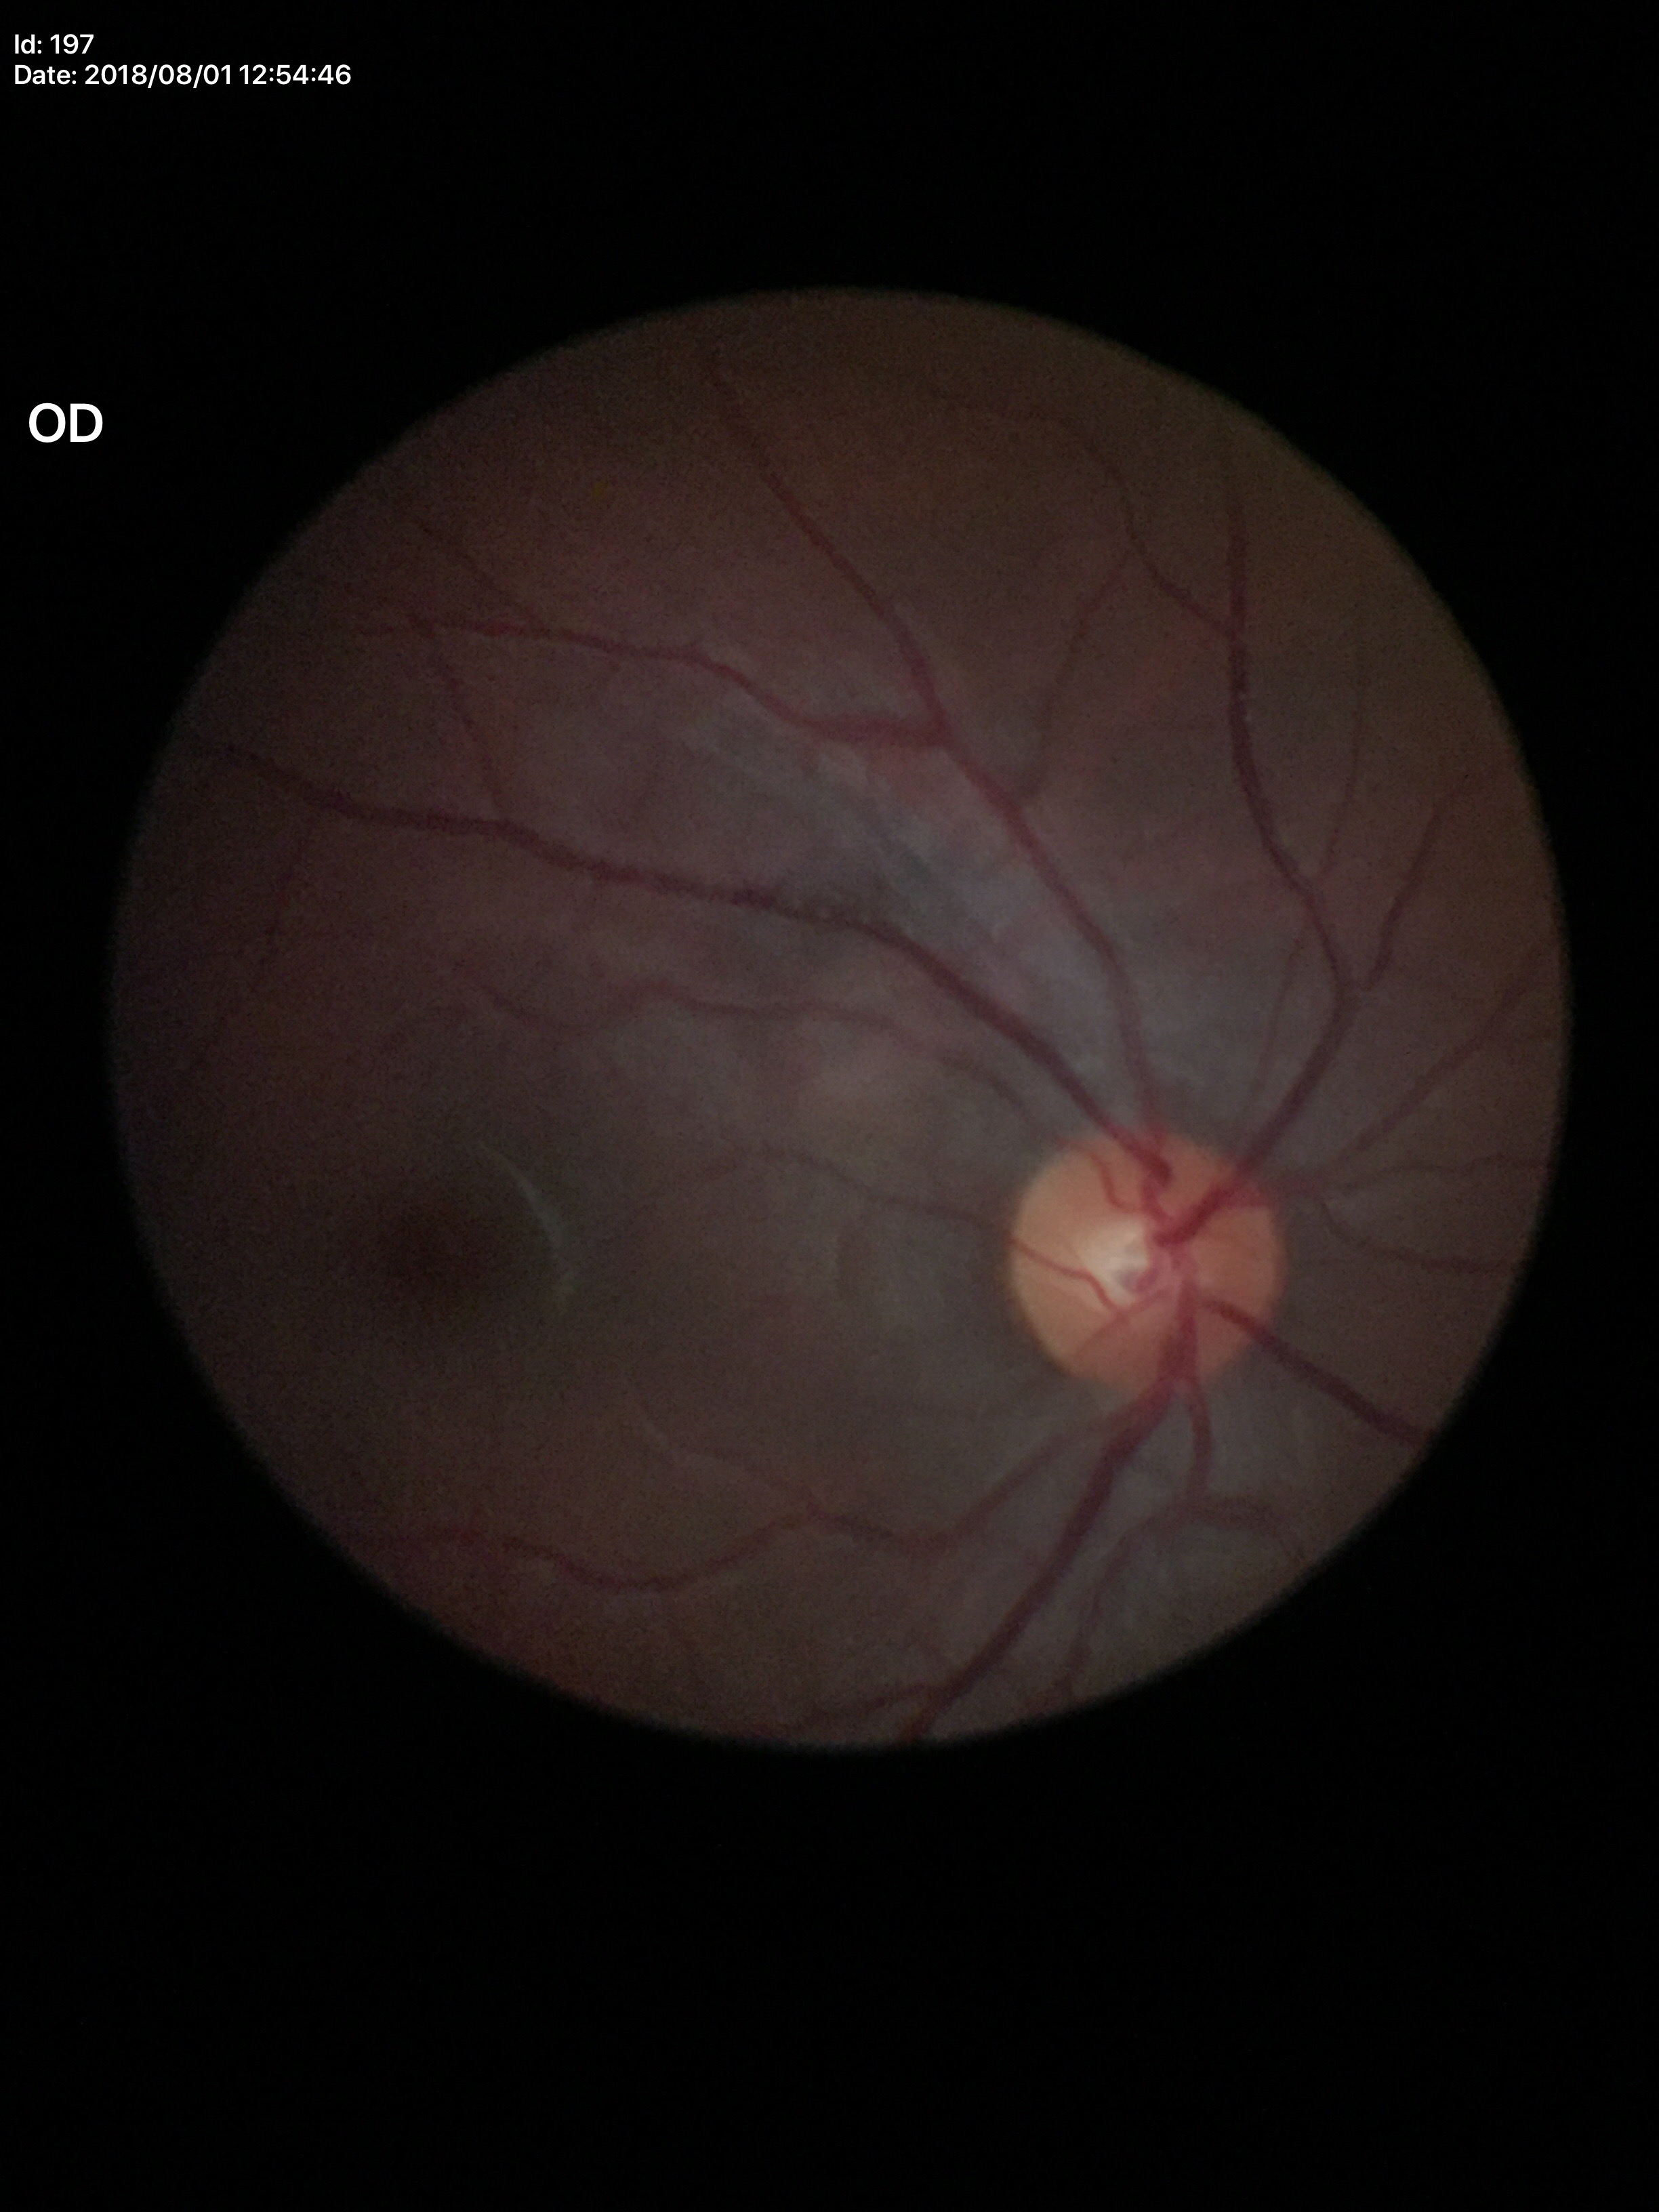
Glaucoma decision: no suspicious findings (unanimous normal call). Vertical CDR is 0.47. Area C/D ratio: 0.22.